2352 by 1568 pixels: 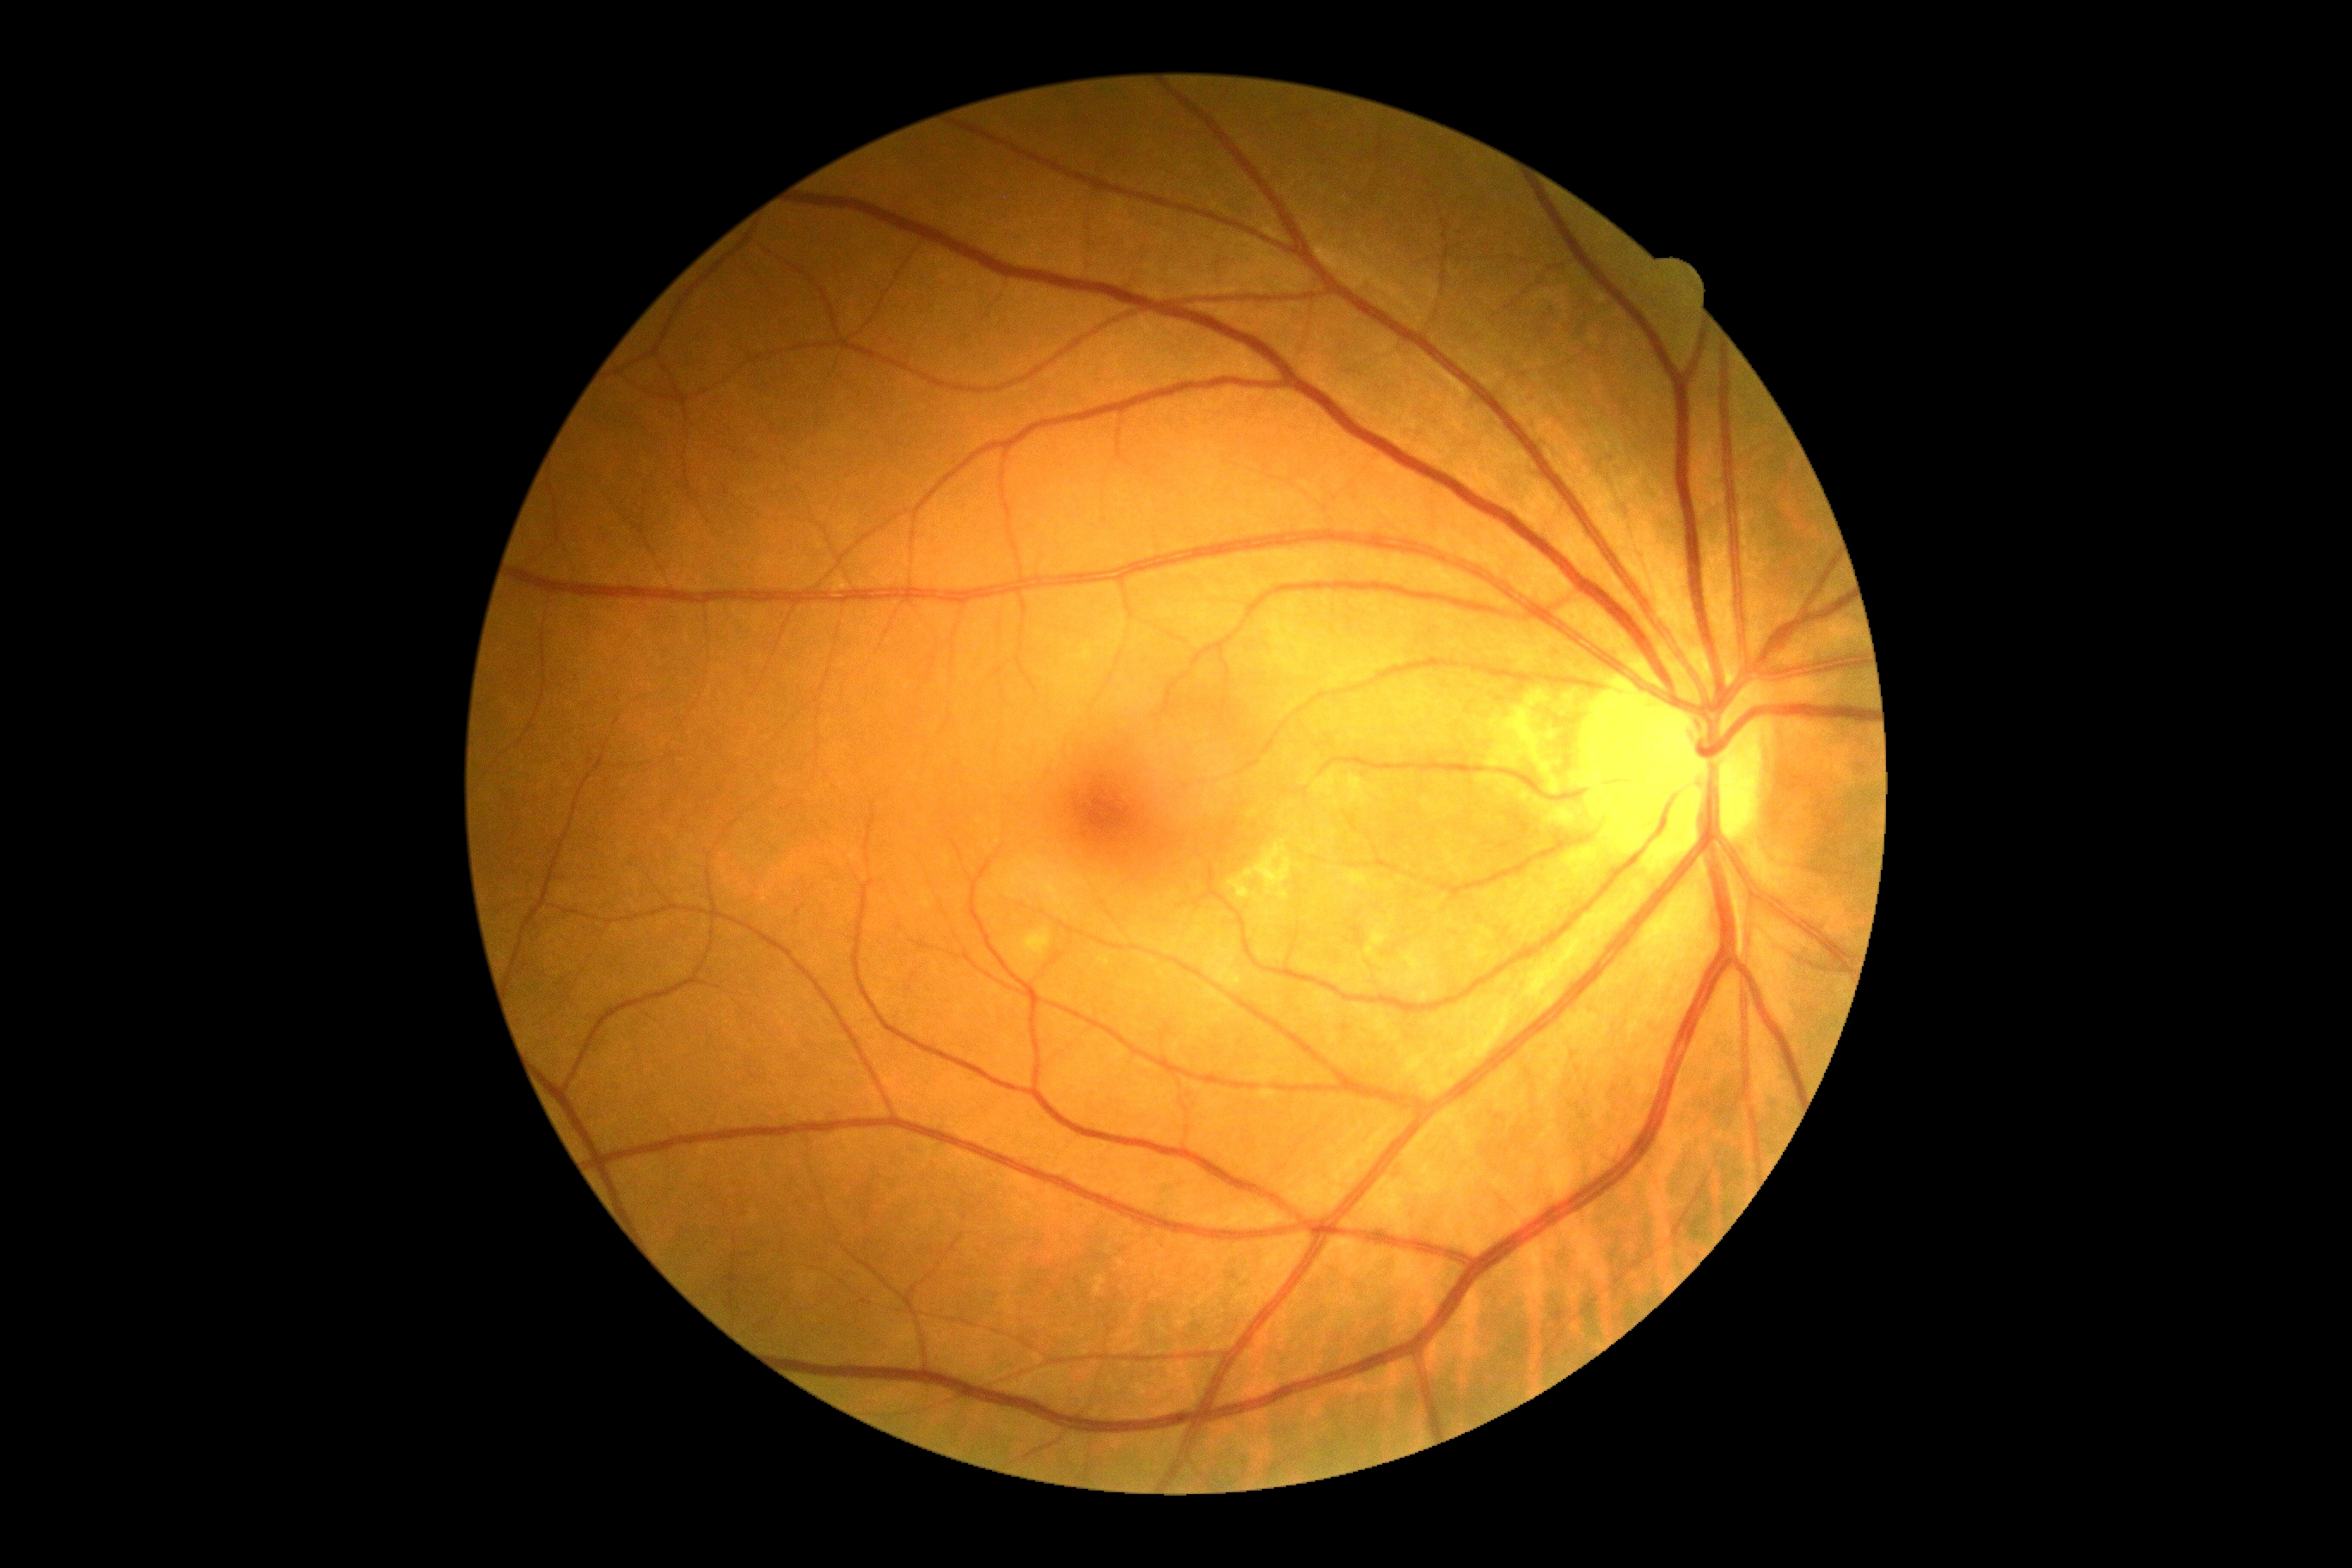

  dr_grade: 0